Nonmydriatic.
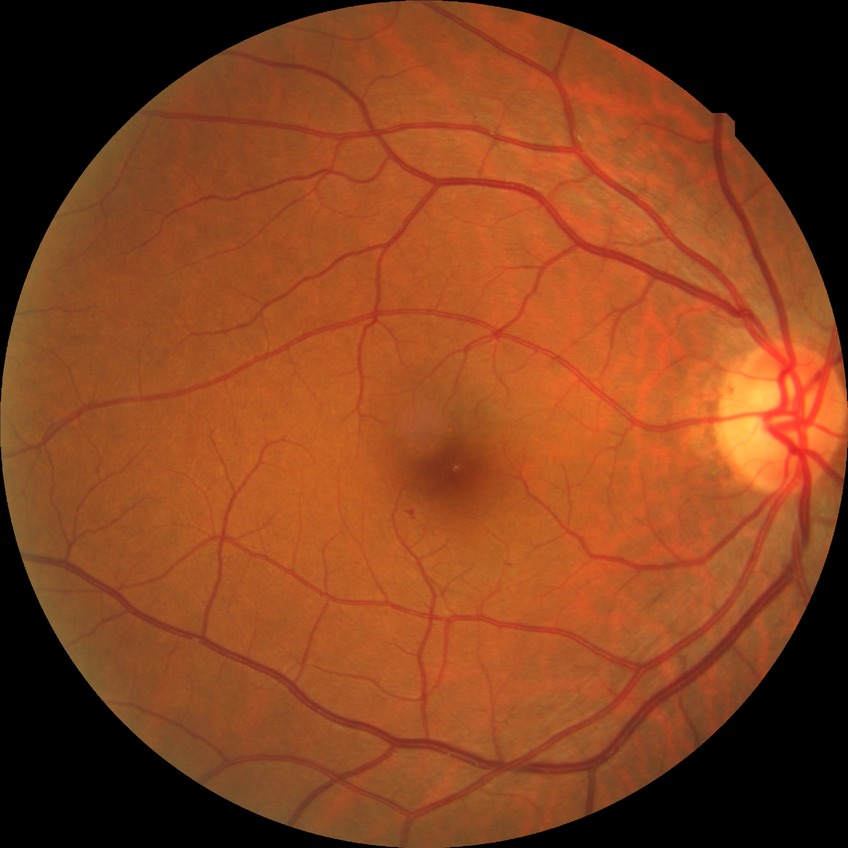 Diabetic retinopathy (DR) is no diabetic retinopathy (NDR).